Diabetic retinopathy graded by the modified Davis classification · no pharmacologic dilation · 848 by 848 pixels · acquired with a NIDEK AFC-230: 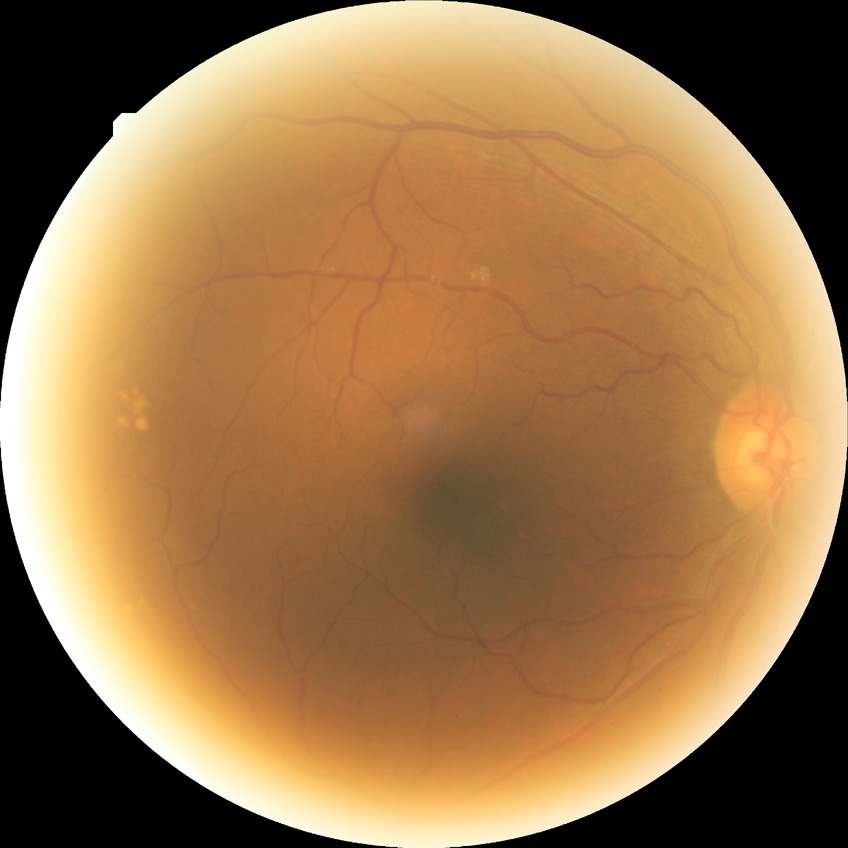
Diabetic retinopathy (DR): NDR (no diabetic retinopathy).